Graded on the modified Davis scale. Acquired with a NIDEK AFC-230:
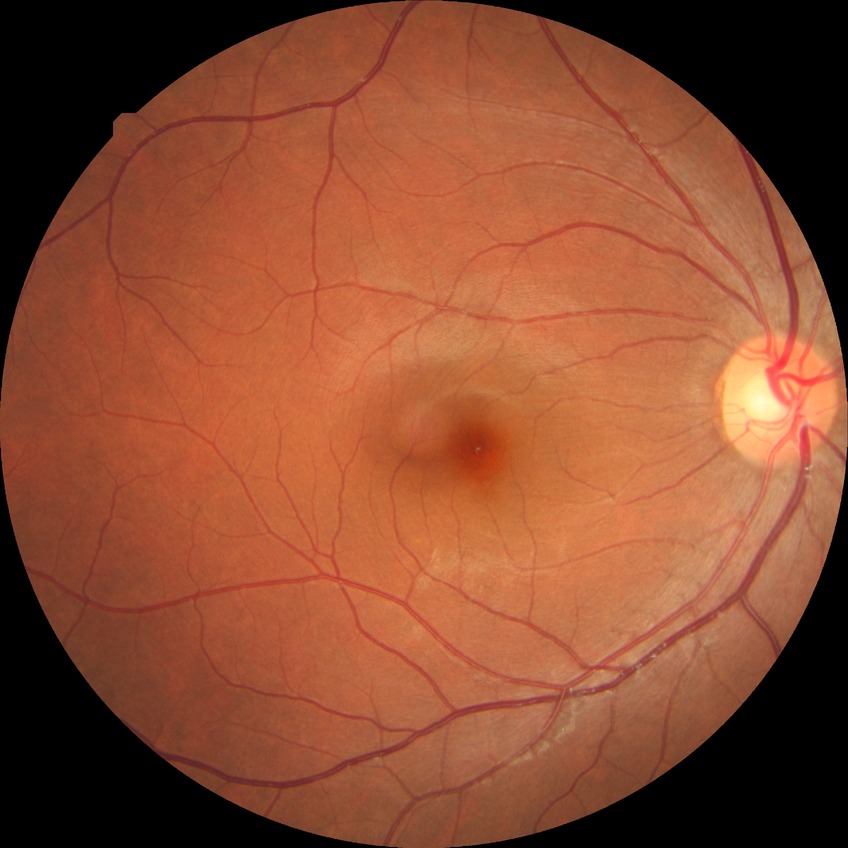

diabetic retinopathy (DR): no diabetic retinopathy (NDR).